Non-mydriatic fundus camera
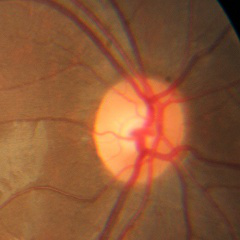 Findings consistent with no glaucomatous optic neuropathy.